Graded on the modified Davis scale · 848 by 848 pixels
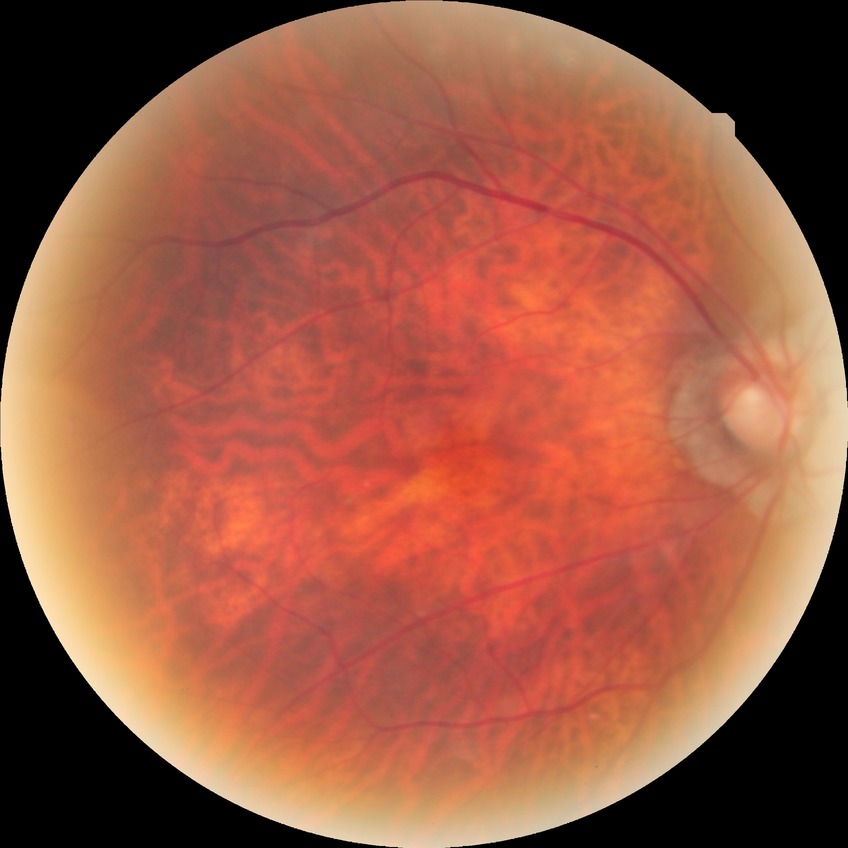

Davis DR grade: NDR.